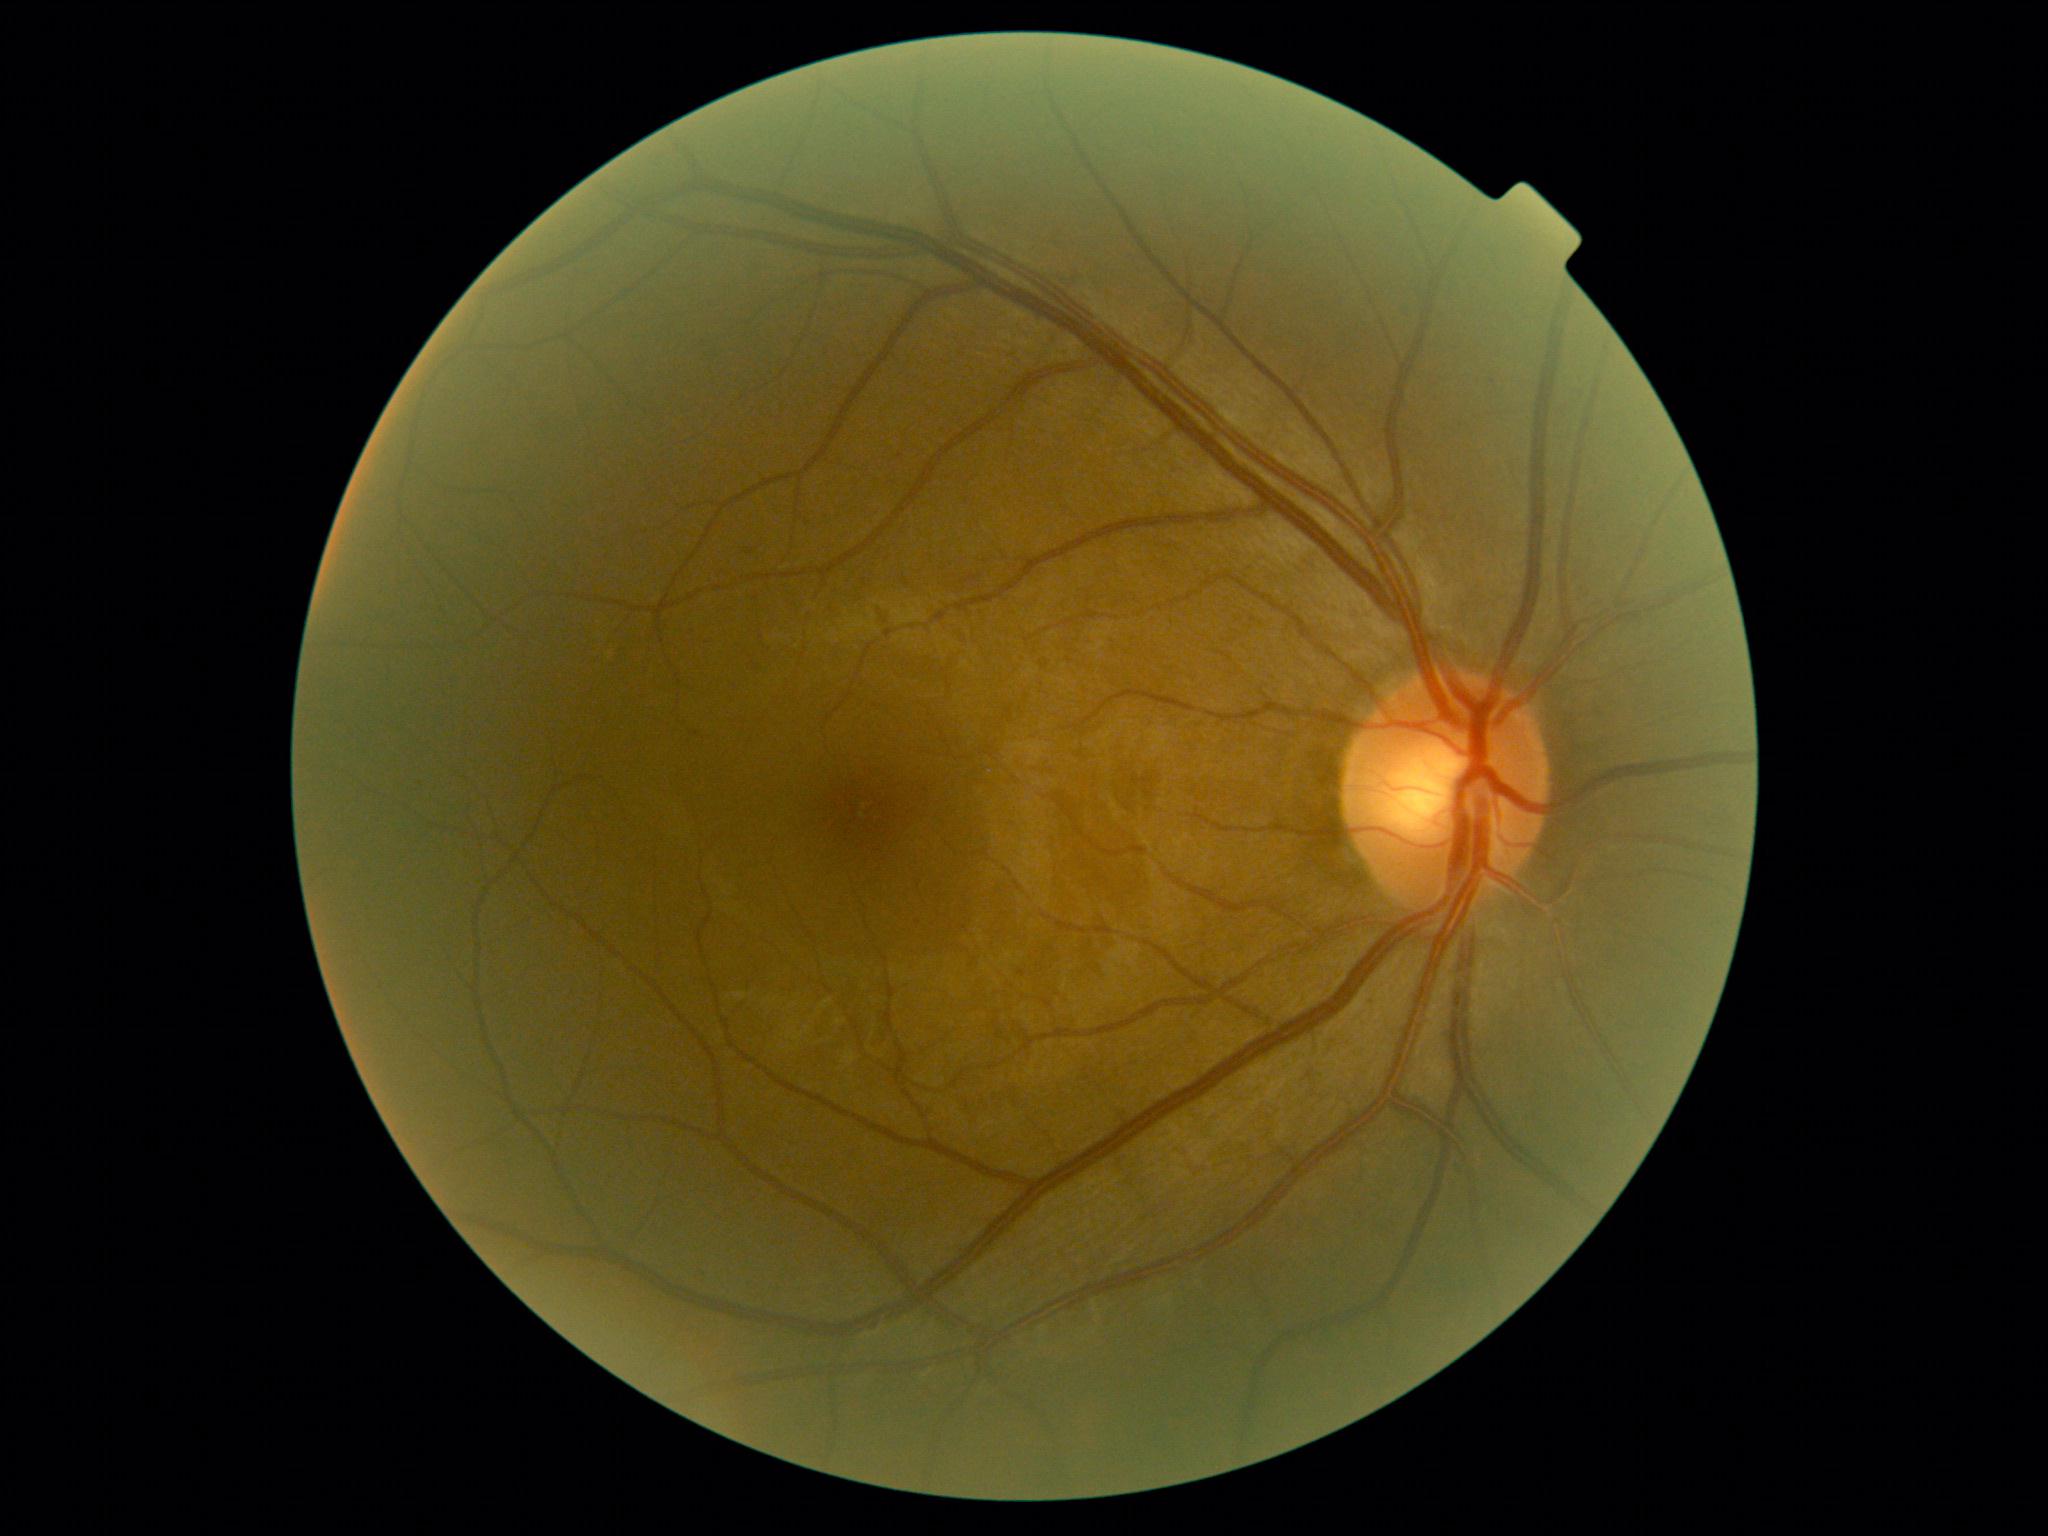

DR stage is mild NPDR (grade 1) — presence of microaneurysms only.